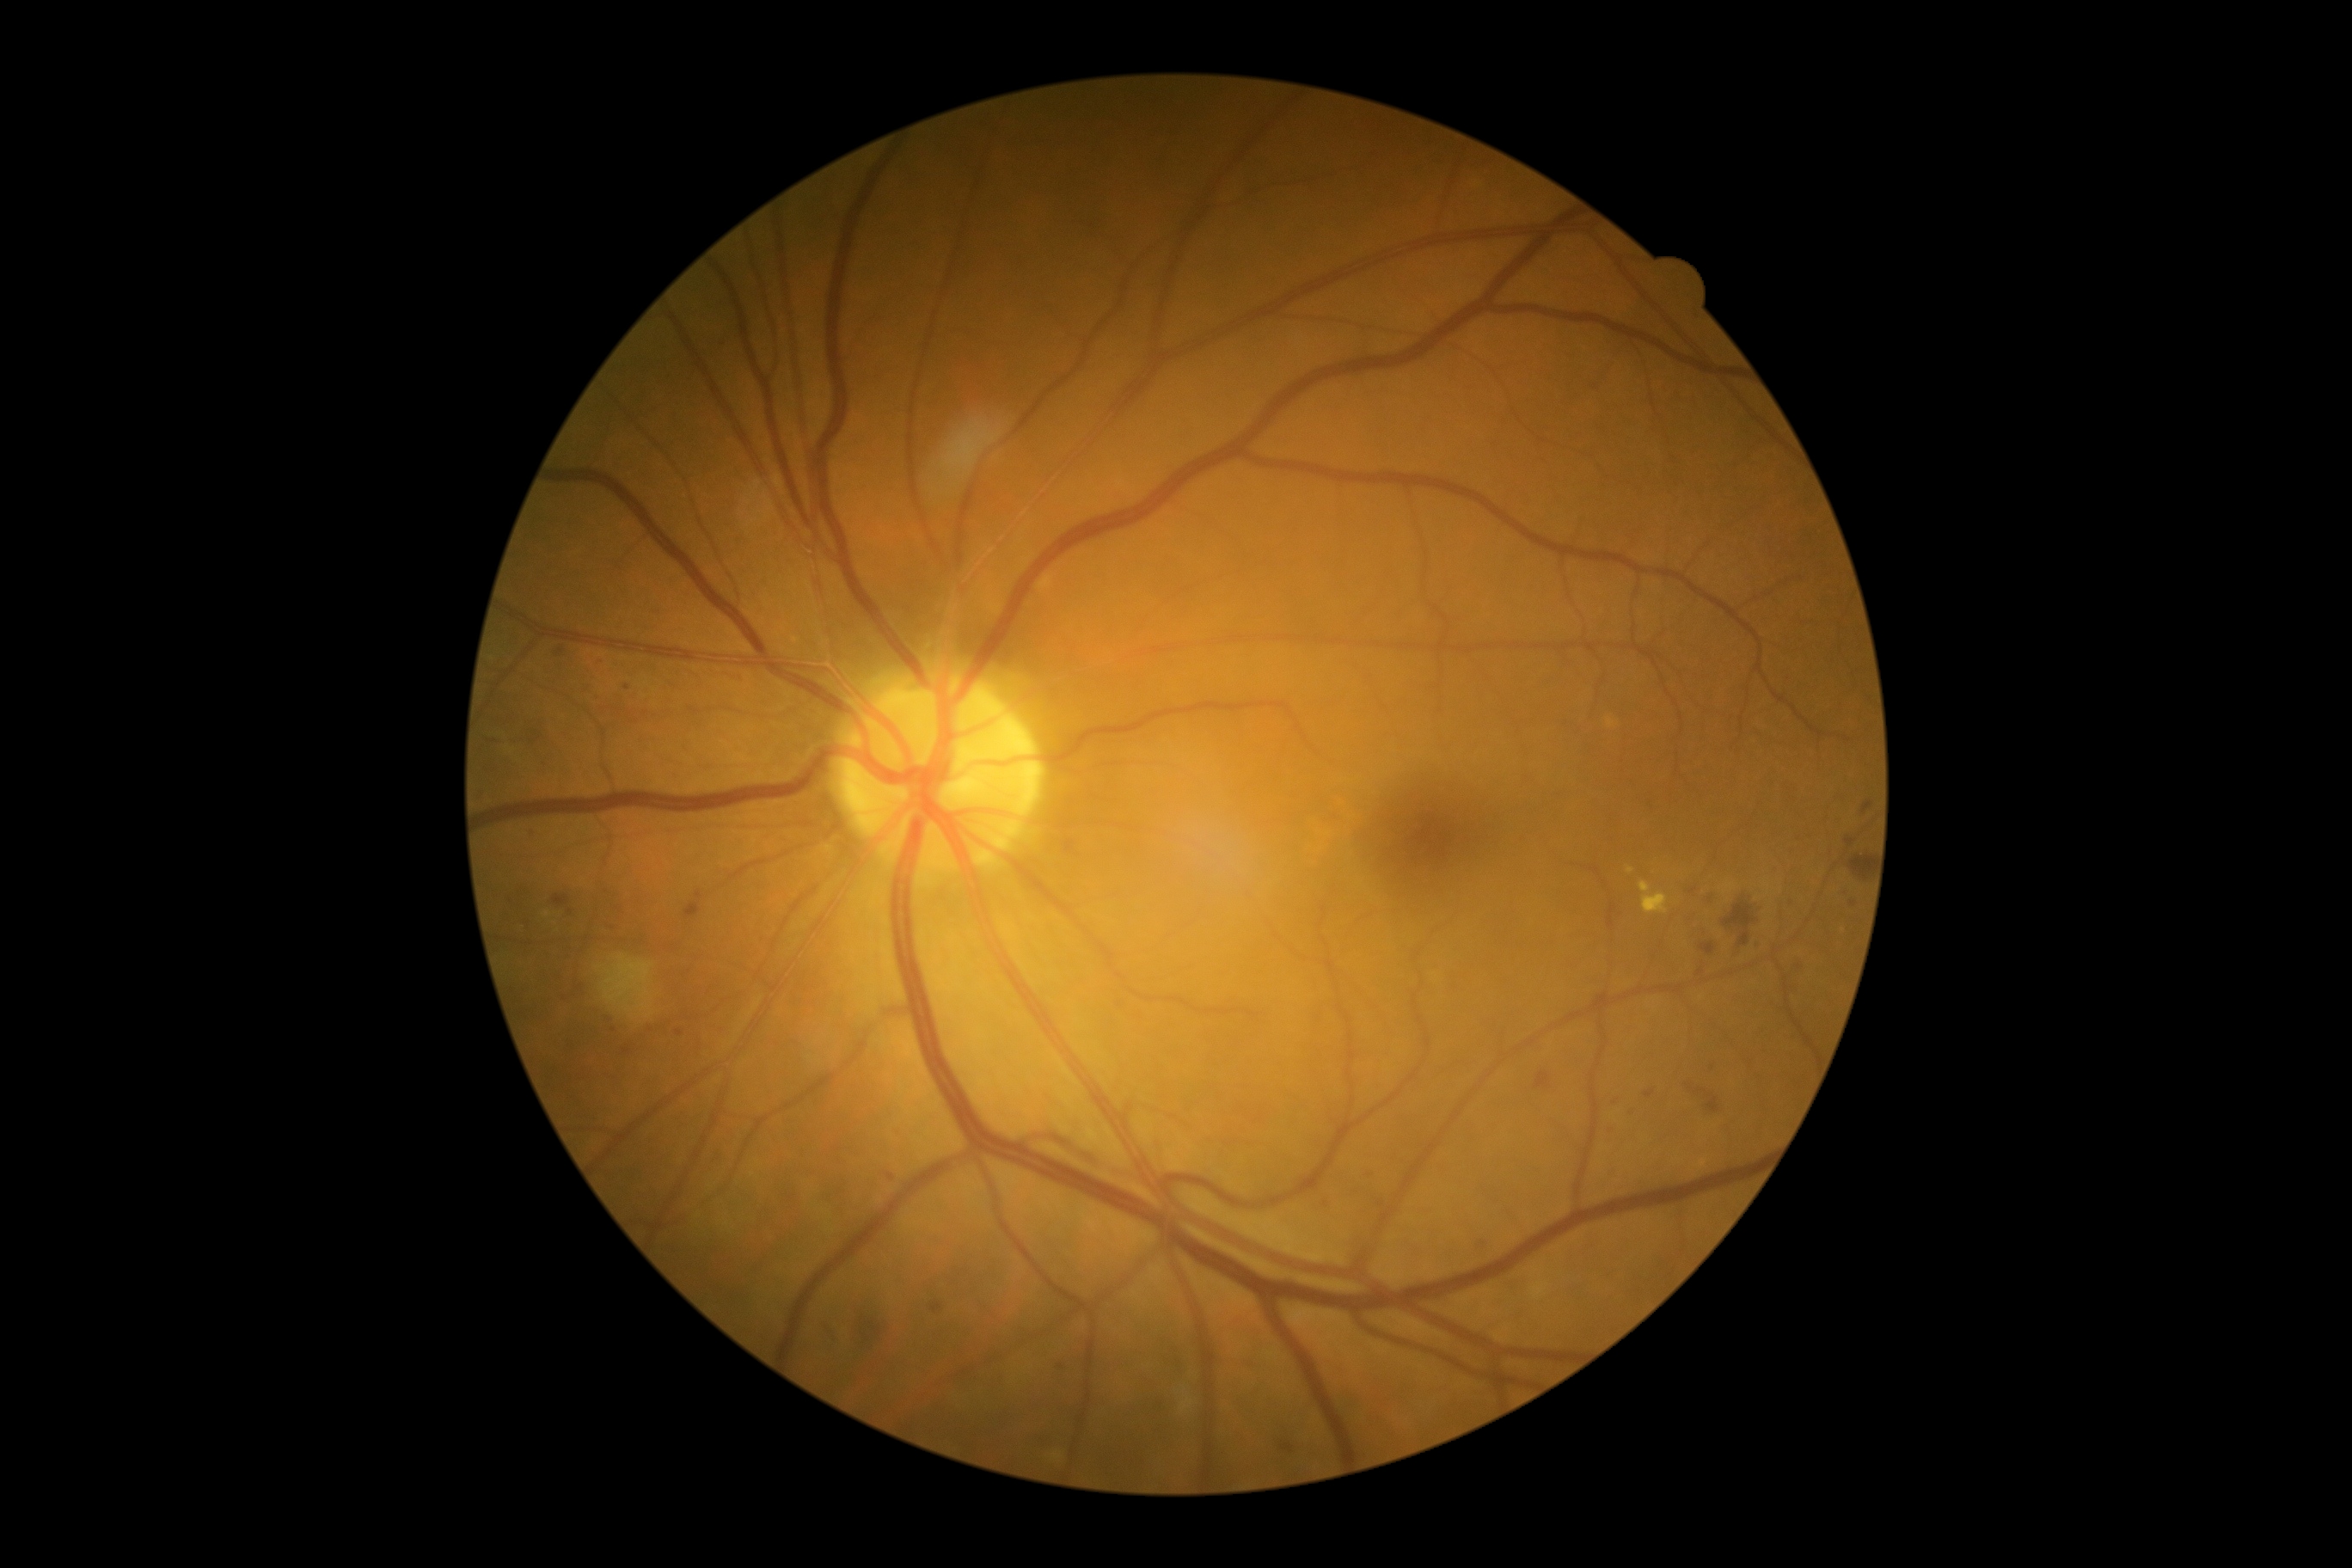

{"partial": true, "dr_grade": 2, "dr_grade_name": "moderate NPDR", "lesions": {"he": [[864, 1318, 886, 1352], [1863, 800, 1875, 816], [1849, 855, 1871, 881], [1534, 1072, 1552, 1089], [1724, 900, 1760, 948], [685, 903, 701, 919], [1687, 1079, 1724, 1122], [1696, 969, 1705, 976], [1700, 943, 1717, 955], [553, 895, 570, 907]], "he_small": [[1854, 904]], "ma": [[558, 647, 565, 656], [1608, 1099, 1617, 1108], [1364, 1167, 1378, 1184], [1846, 840, 1856, 847], [525, 830, 534, 838], [1755, 940, 1763, 950], [1608, 1124, 1614, 1134], [1708, 898, 1717, 910], [1280, 1442, 1295, 1454], [695, 891, 702, 900]], "ma_small": [[627, 688], [1792, 903], [1800, 967], [1326, 1204], [570, 913]], "ex": [[1053, 1452, 1063, 1461], [1180, 1399, 1194, 1414], [1627, 867, 1636, 874], [1639, 881, 1669, 916]], "se": null}}